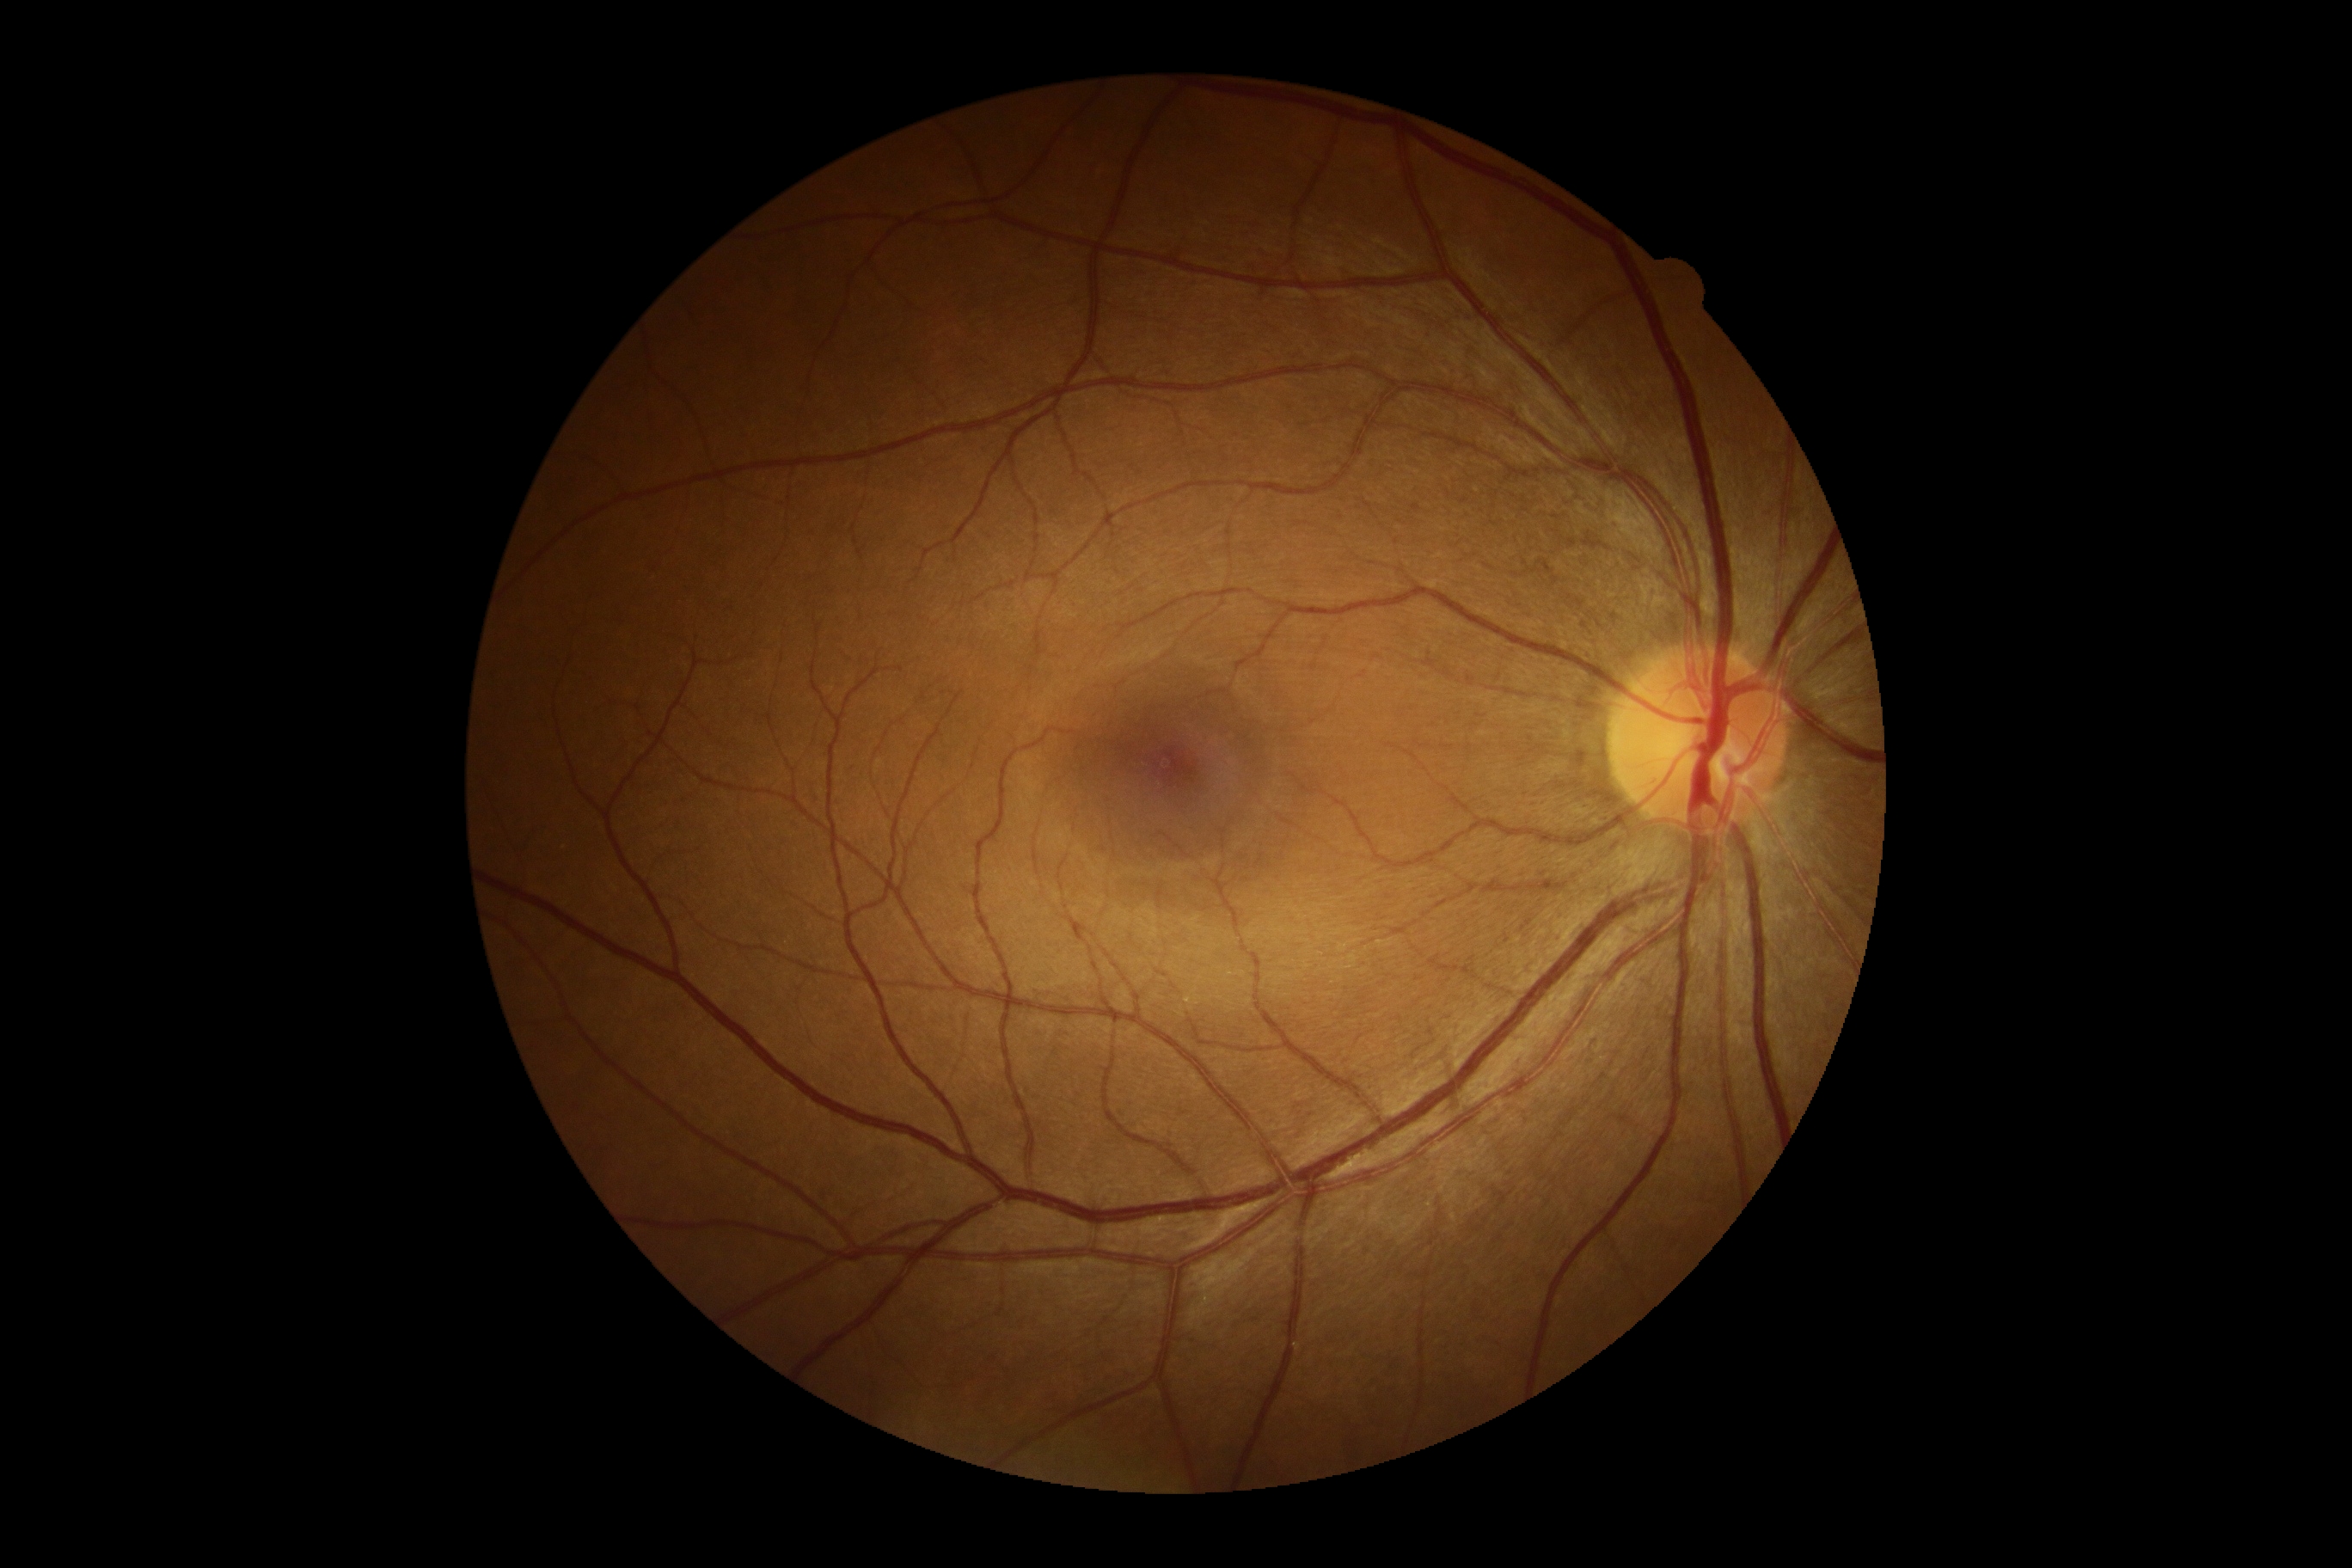 DR stage@grade 0 (no apparent retinopathy).